Infant wide-field fundus photograph · 640 x 480 pixels.
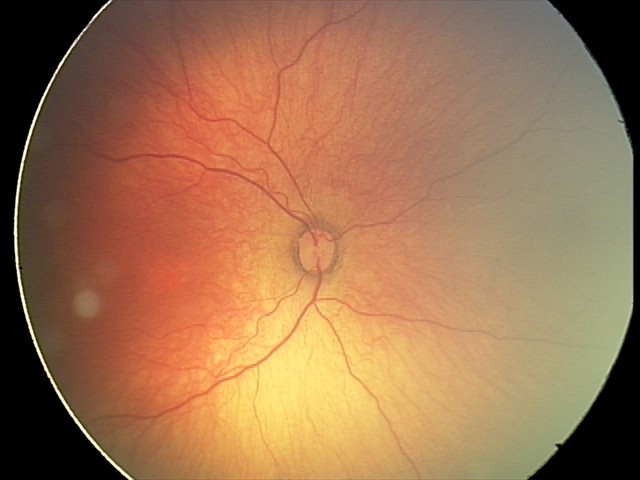
Screening examination consistent with status post ROP. No plus disease.